Camera: Nidek AFC-330:
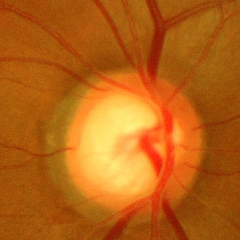 Glaucoma diagnosis: advanced glaucomatous optic neuropathy.